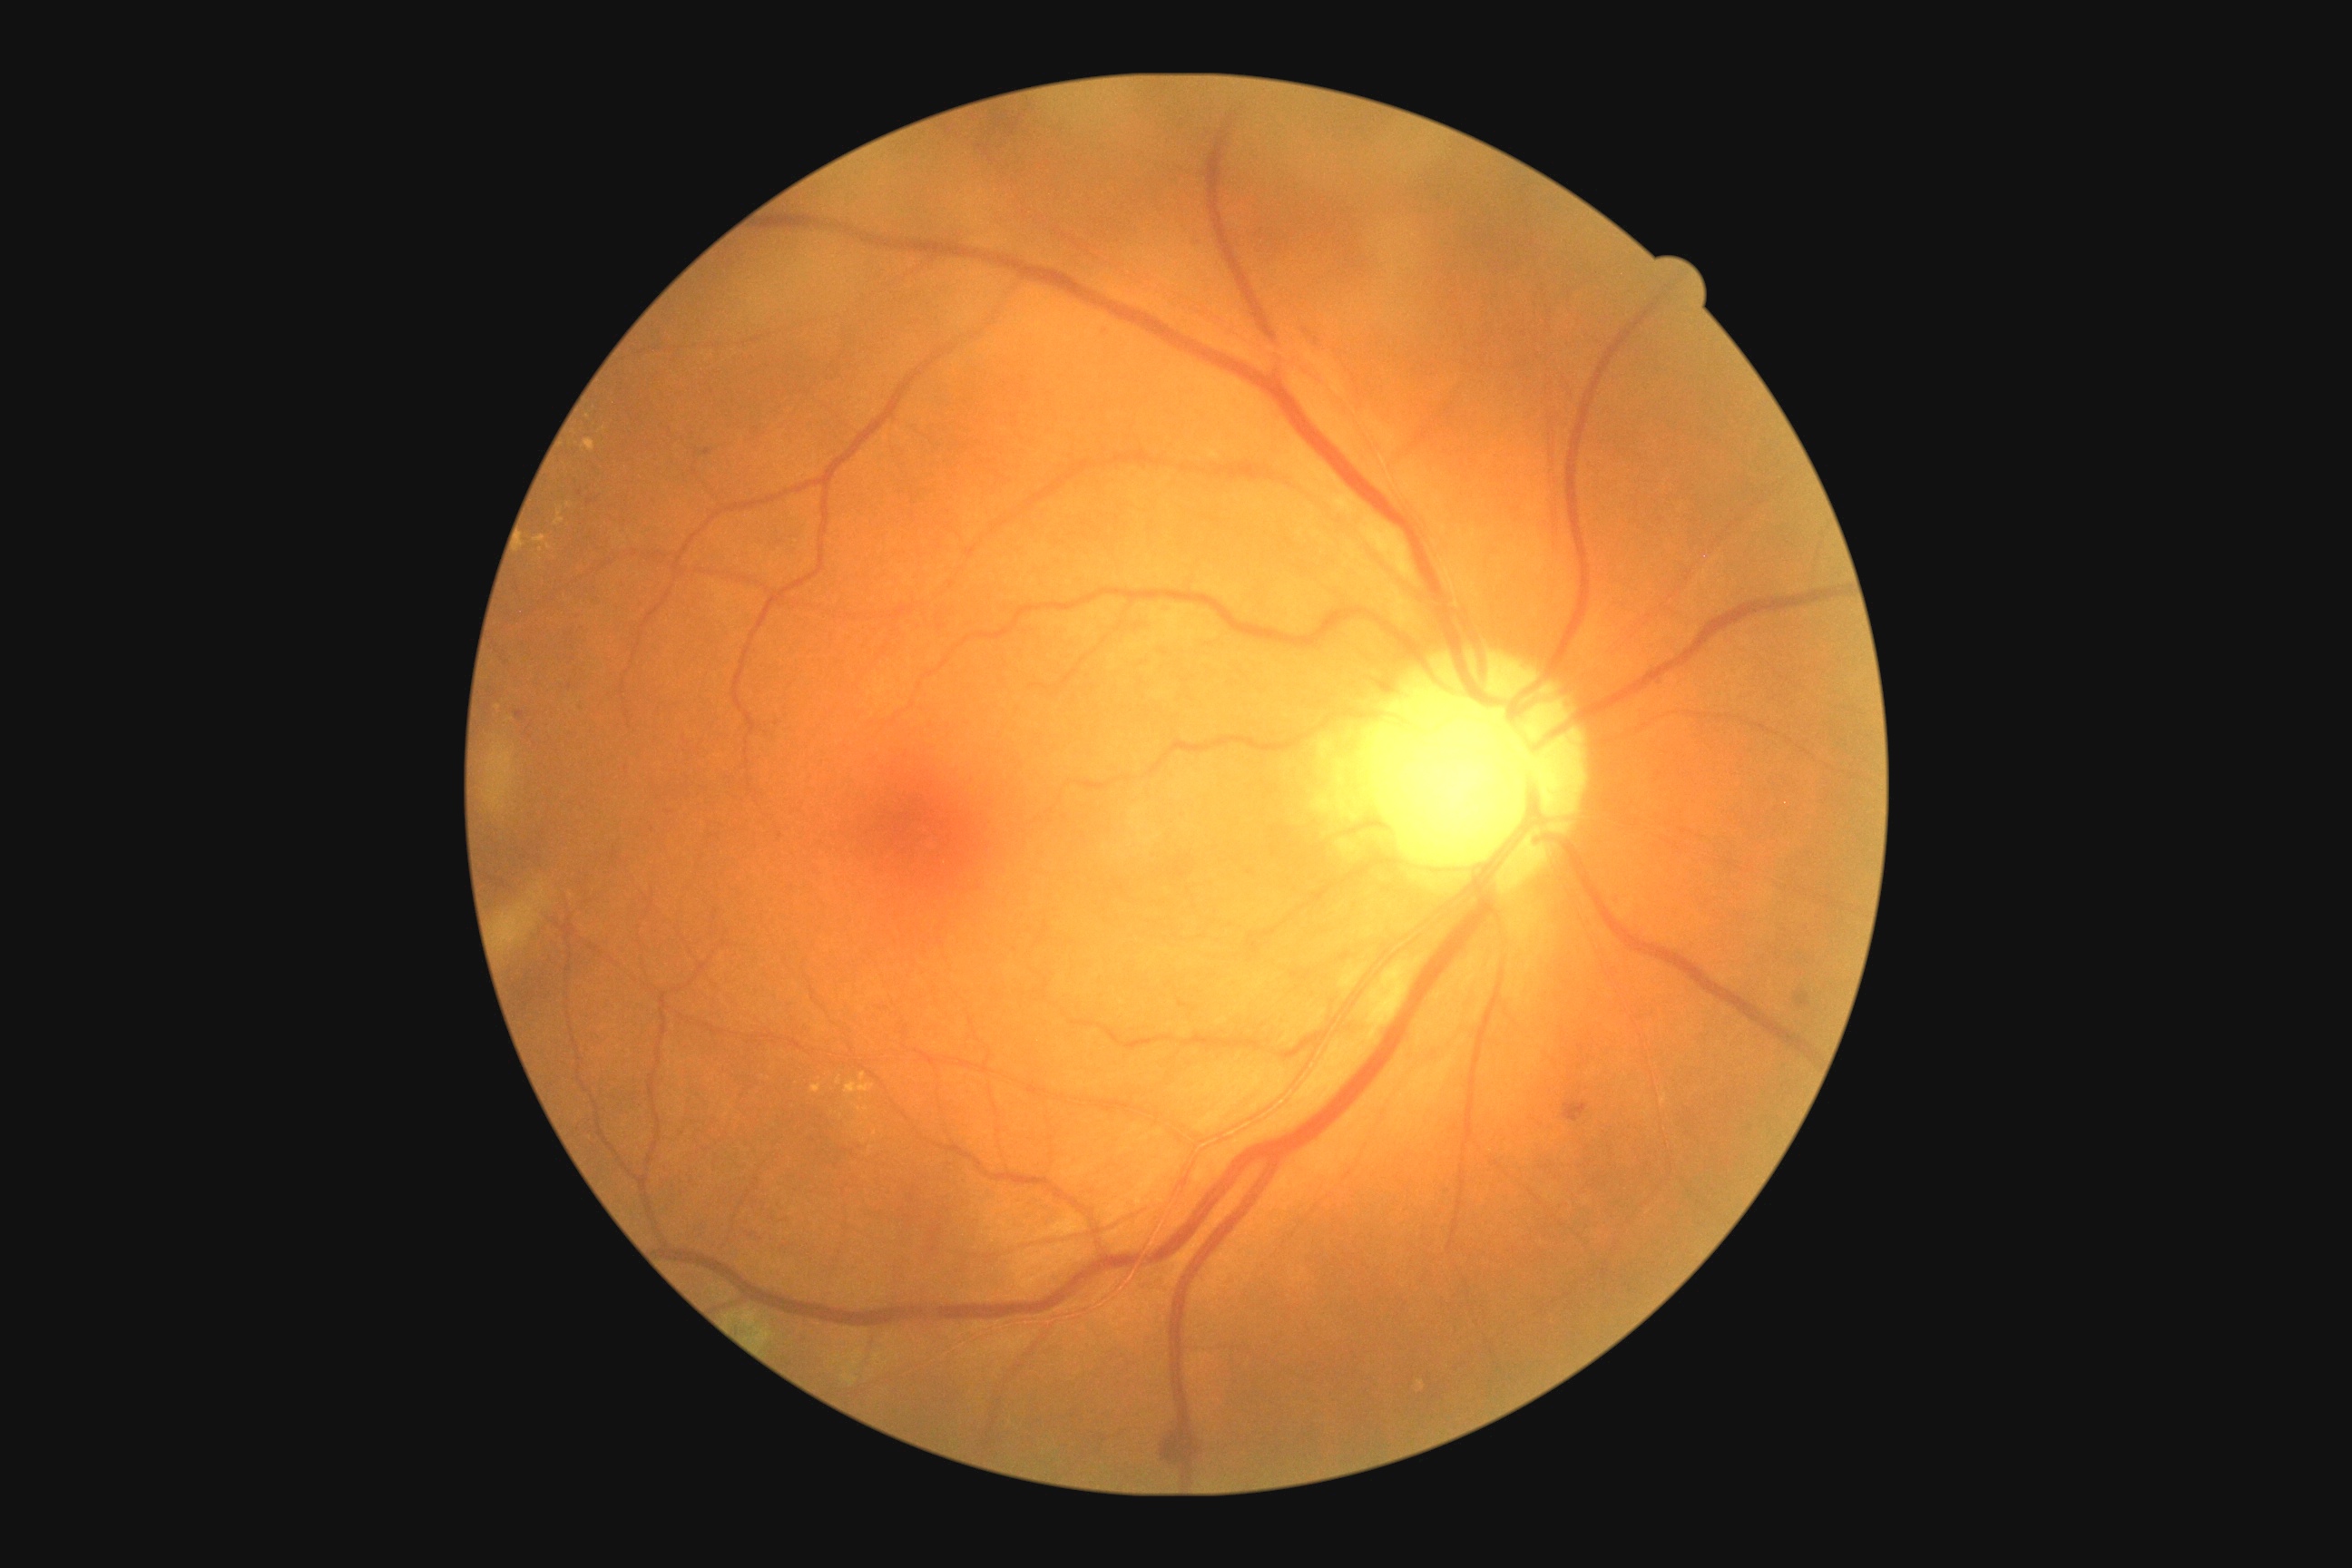
Diabetic retinopathy (DR) is moderate NPDR (grade 2)
Representative lesions:
• soft exudates (SEs): absent
• microaneurysms (MAs): absent
• hemorrhages (HEs) (partial): left=1652, top=676, right=1661, bottom=685 | left=1607, top=968, right=1623, bottom=981 | left=1611, top=894, right=1622, bottom=906 | left=1152, top=1424, right=1206, bottom=1469 | left=1366, top=674, right=1400, bottom=694 | left=1190, top=239, right=1200, bottom=248 | left=1097, top=326, right=1110, bottom=337 | left=1798, top=994, right=1810, bottom=1008 | left=516, top=710, right=524, bottom=720 | left=1300, top=328, right=1328, bottom=353 | left=1565, top=1102, right=1589, bottom=1122
• Smaller HEs around [x=590, y=502] | [x=1581, y=1048] | [x=579, y=493] | [x=707, y=452]
• hard exudates (EXs) (partial): left=859, top=1073, right=867, bottom=1081 | left=554, top=509, right=564, bottom=525 | left=810, top=1084, right=821, bottom=1093 | left=847, top=1083, right=876, bottom=1095 | left=582, top=440, right=594, bottom=453 | left=856, top=1106, right=870, bottom=1112 | left=534, top=536, right=547, bottom=544
• Smaller EXs around [x=542, y=551] | [x=838, y=1080] | [x=510, y=719] | [x=499, y=707] | [x=568, y=505] | [x=875, y=1133] | [x=549, y=547]